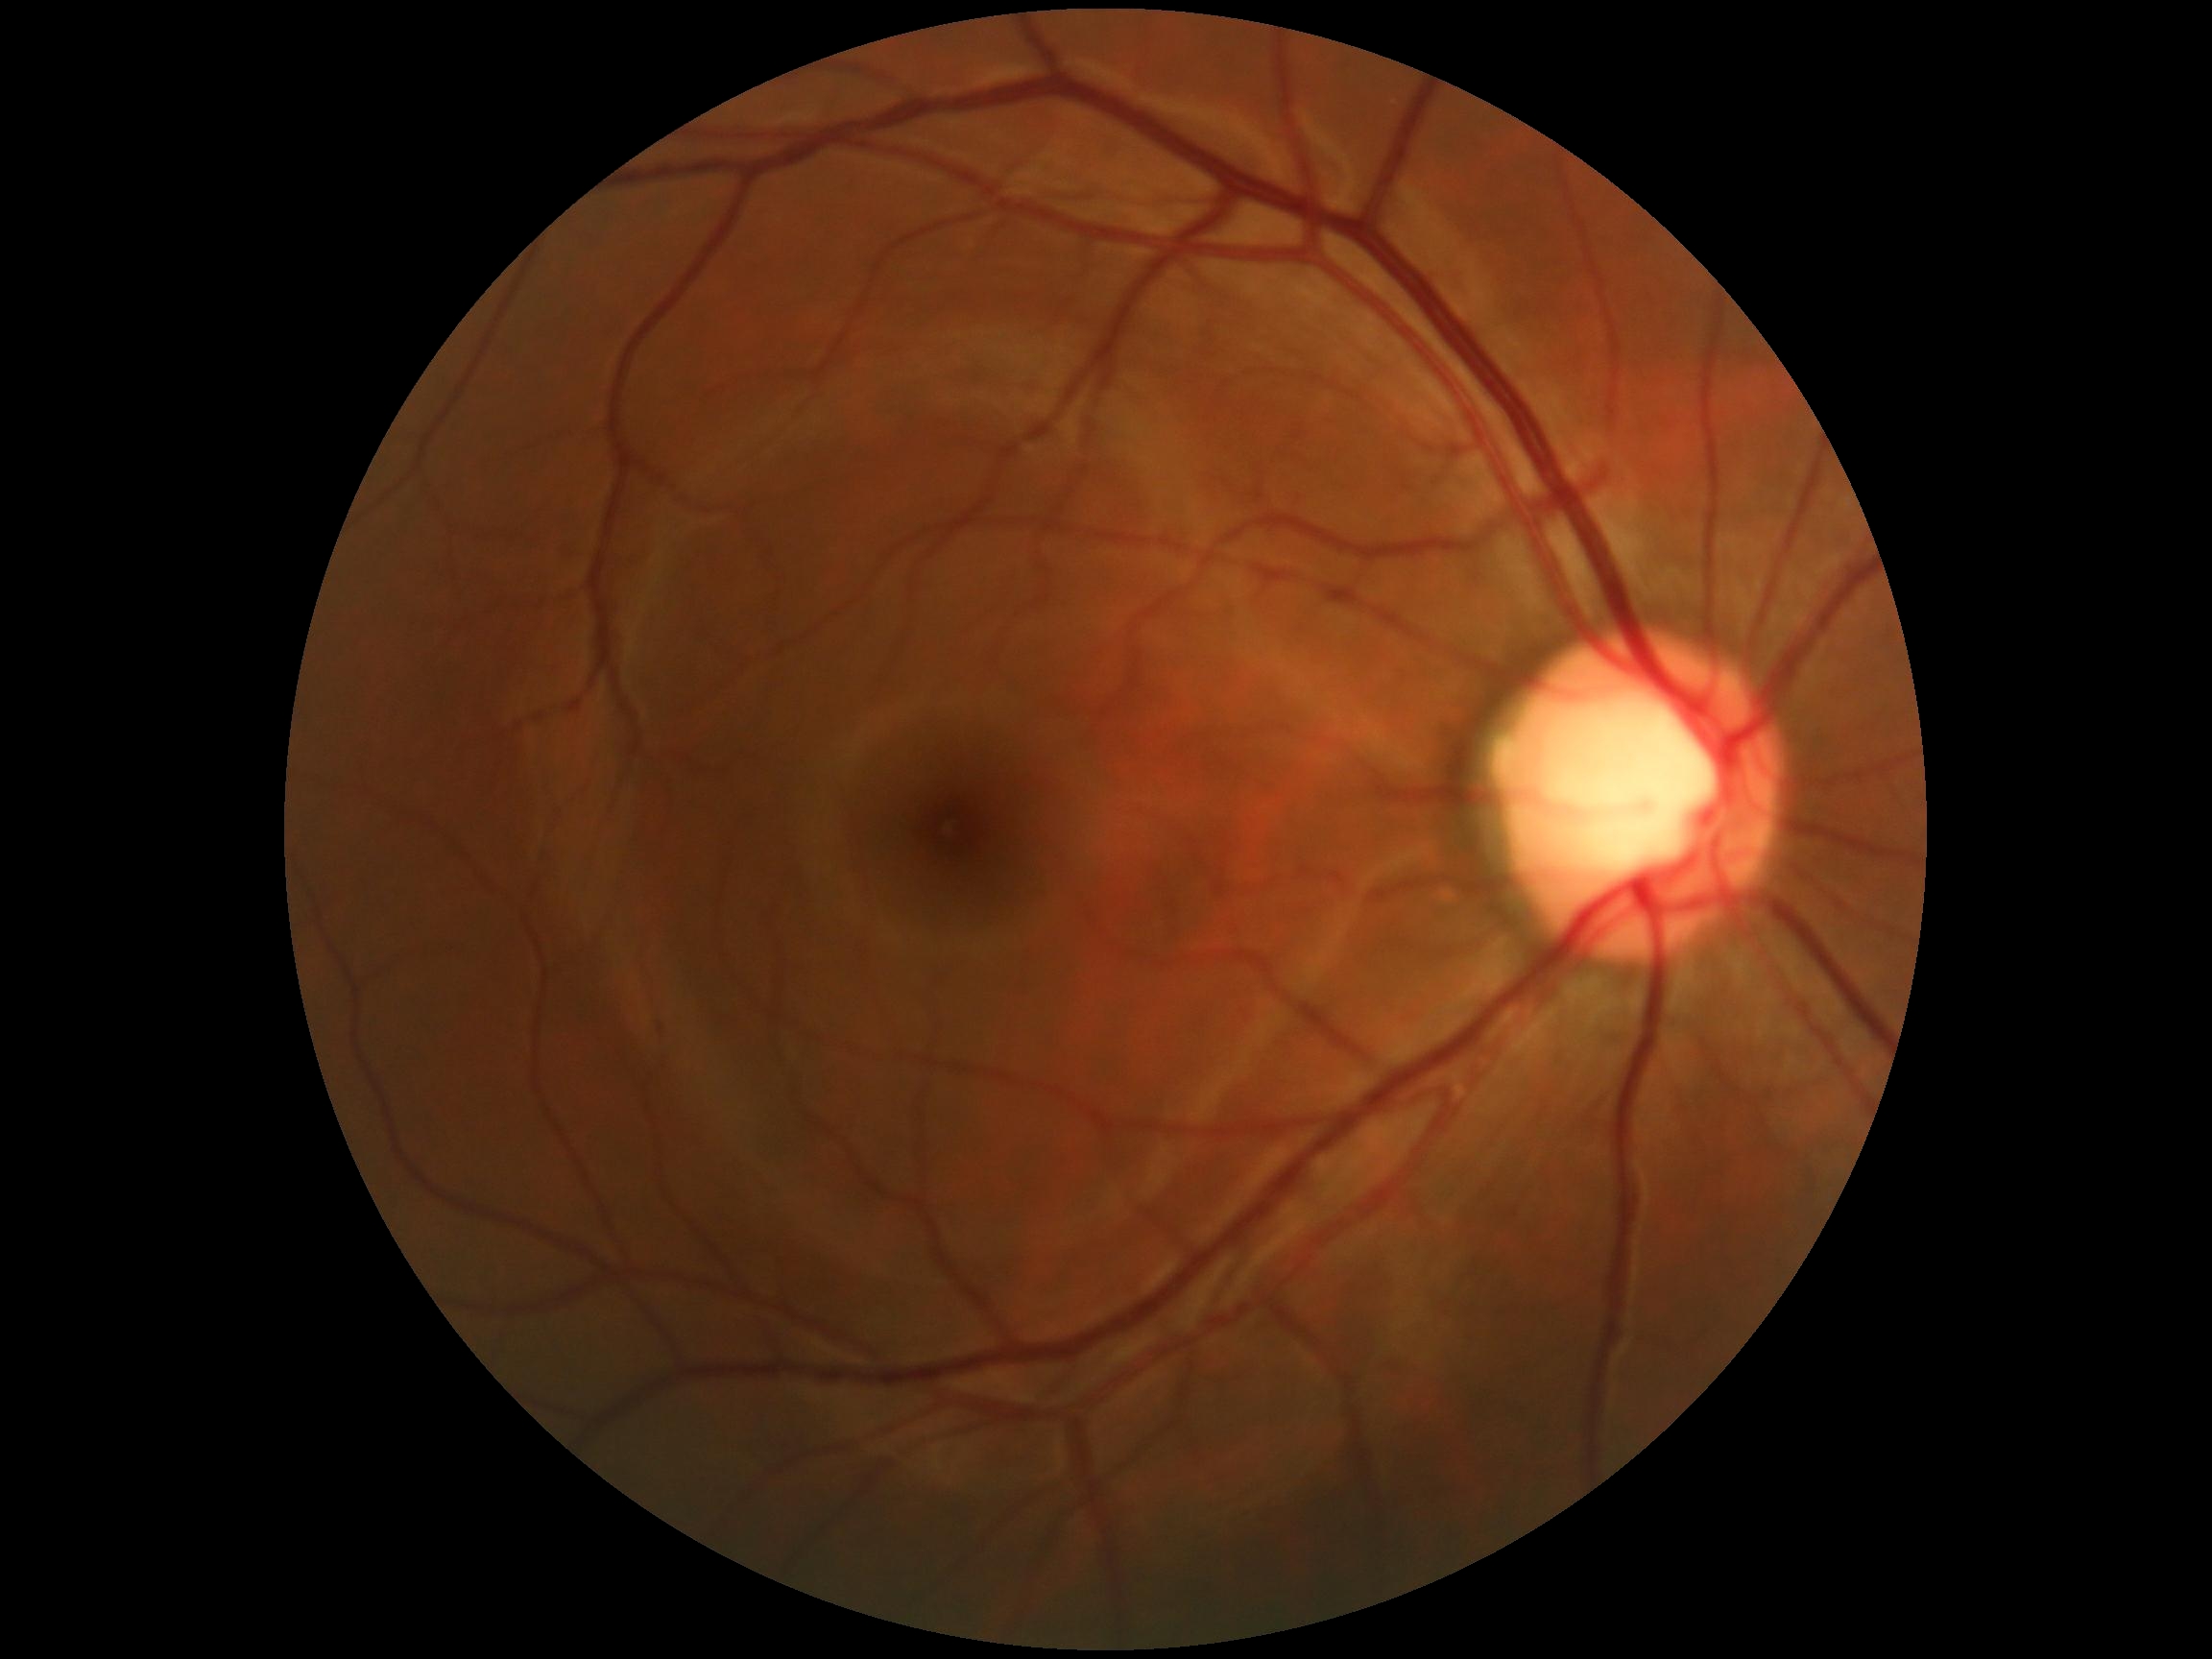 No apparent diabetic retinopathy. Diabetic retinopathy grade: 0/4 — no visible signs of diabetic retinopathy.